640 by 480 pixels. Pediatric wide-field fundus photograph. Acquired on the Clarity RetCam 3 — 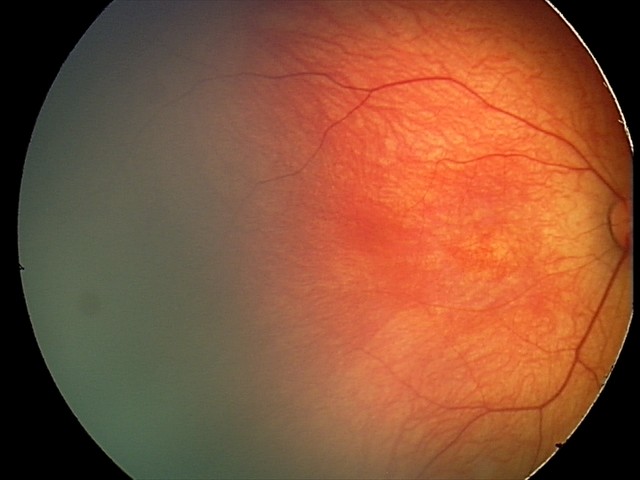 Screening examination consistent with retinal hemorrhages.